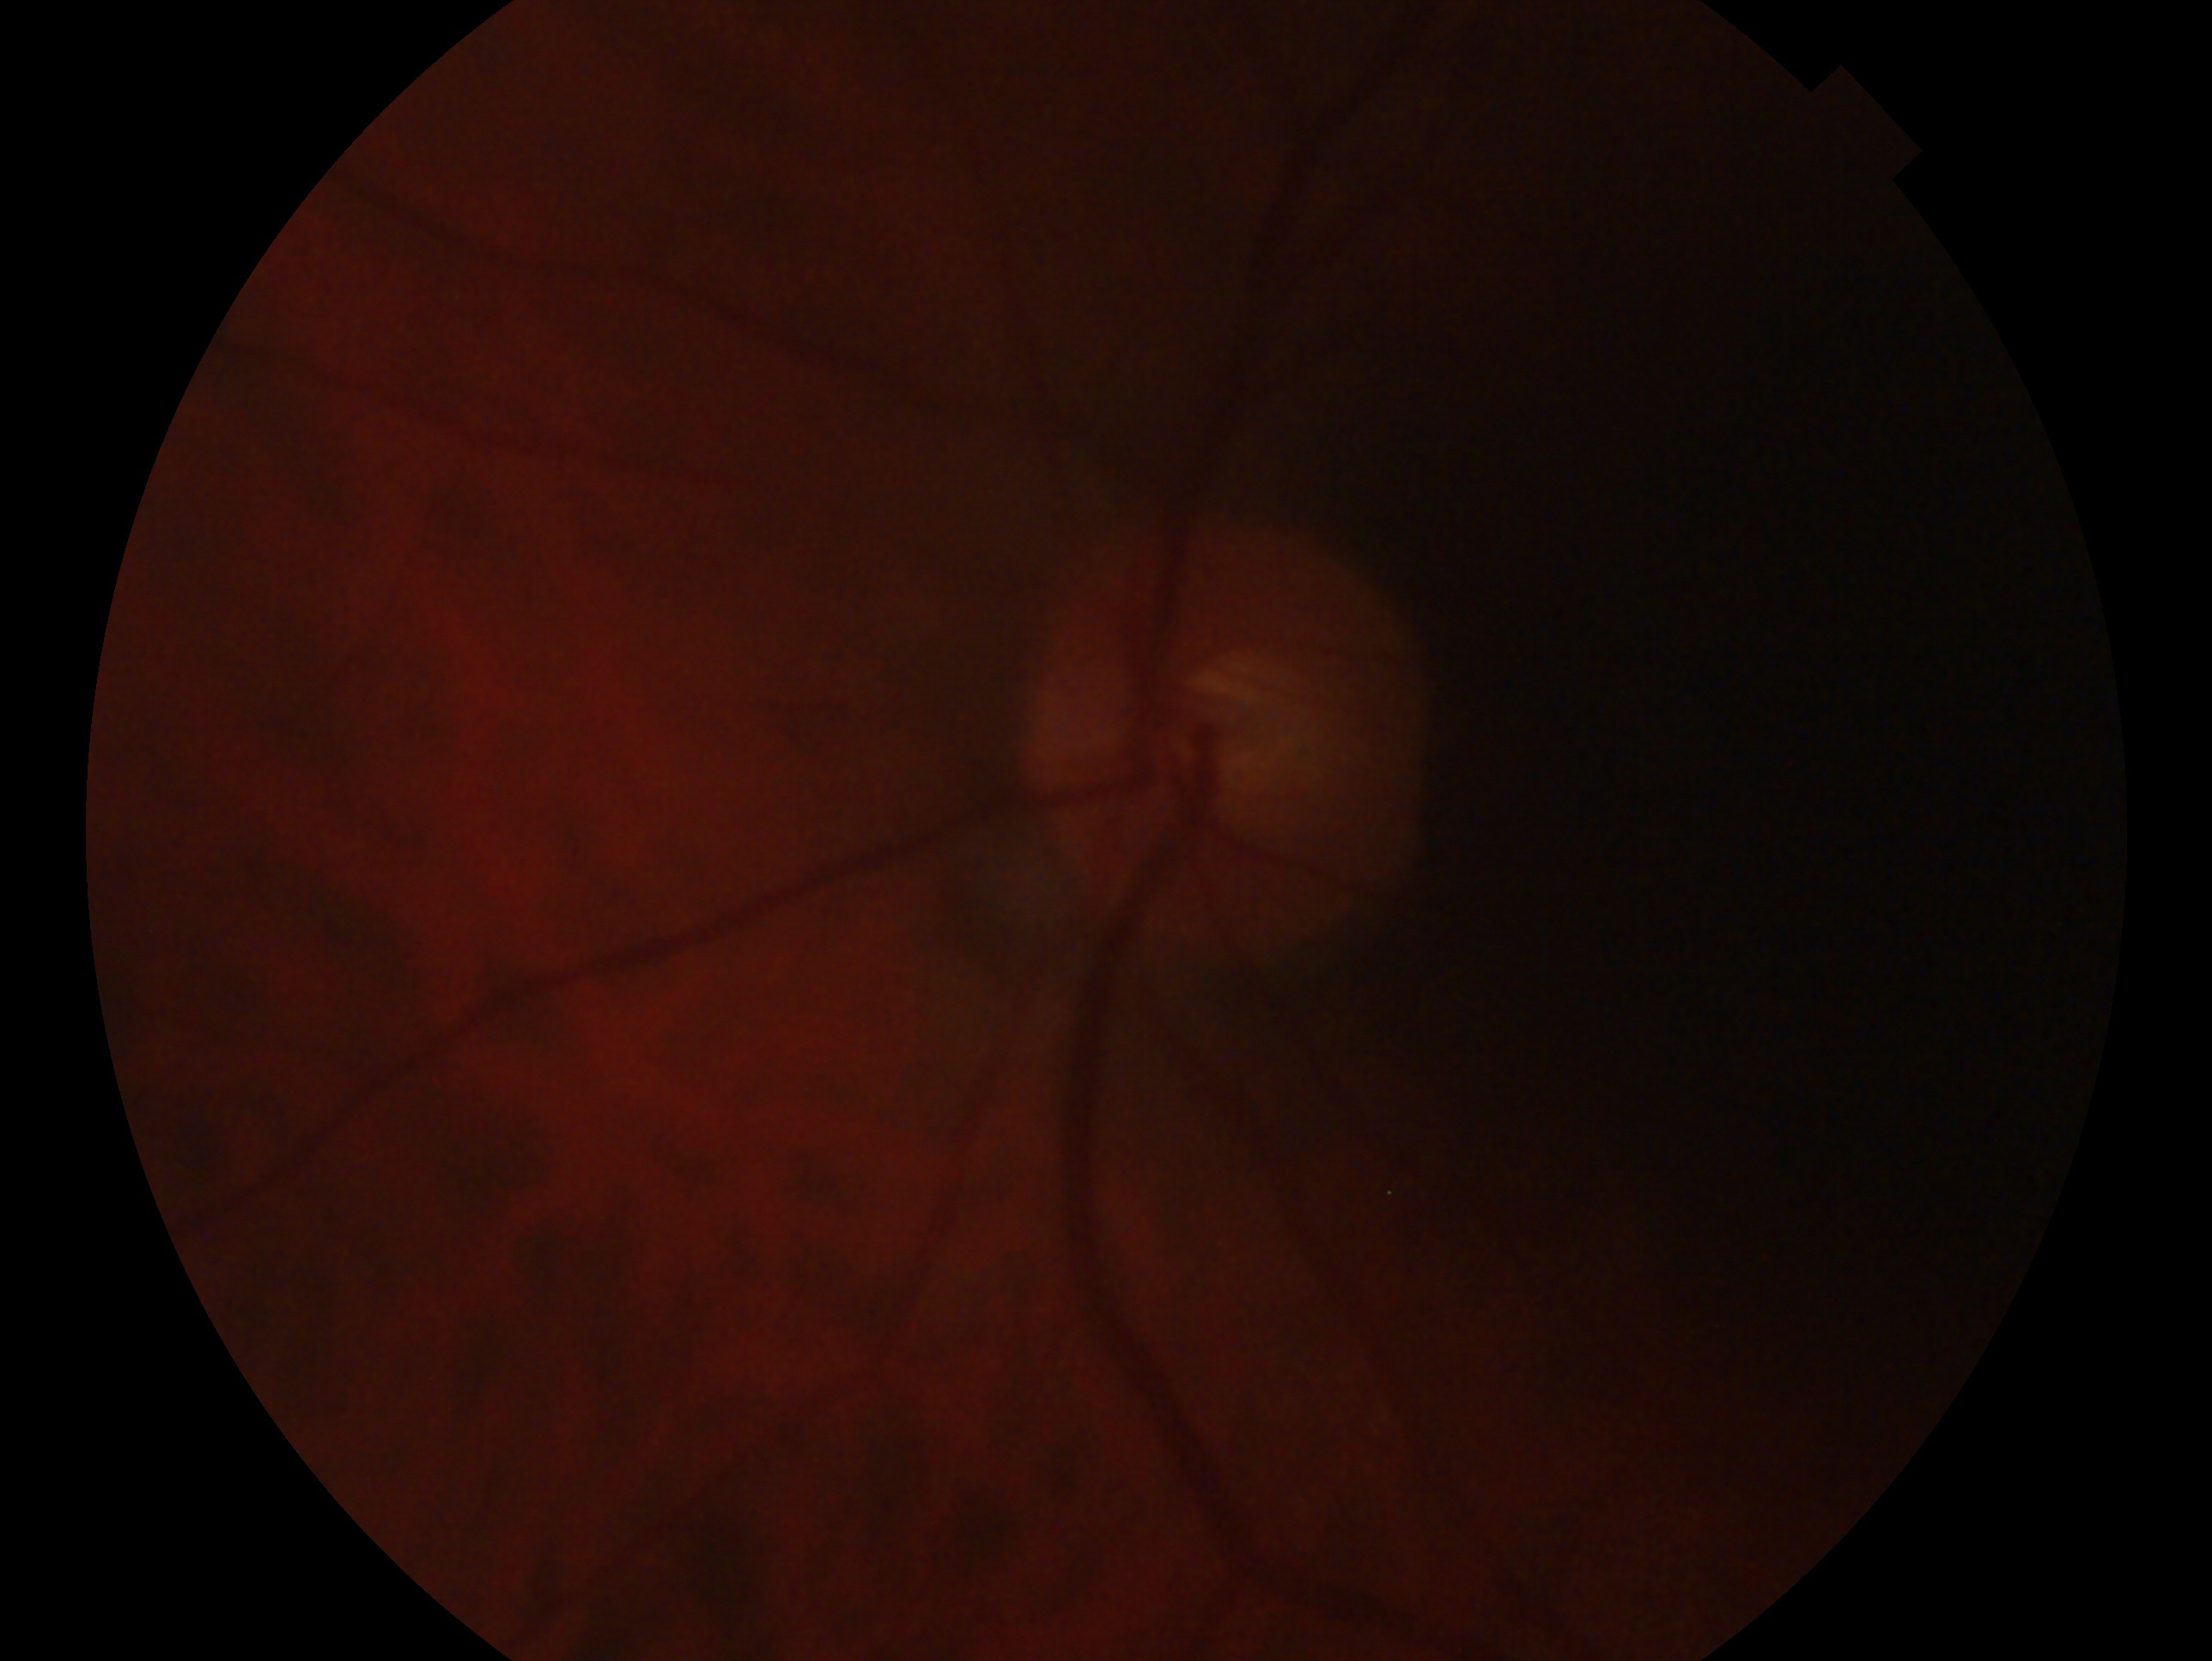

This is the OS.
Impression: no evidence of glaucoma.